Modified Davis classification
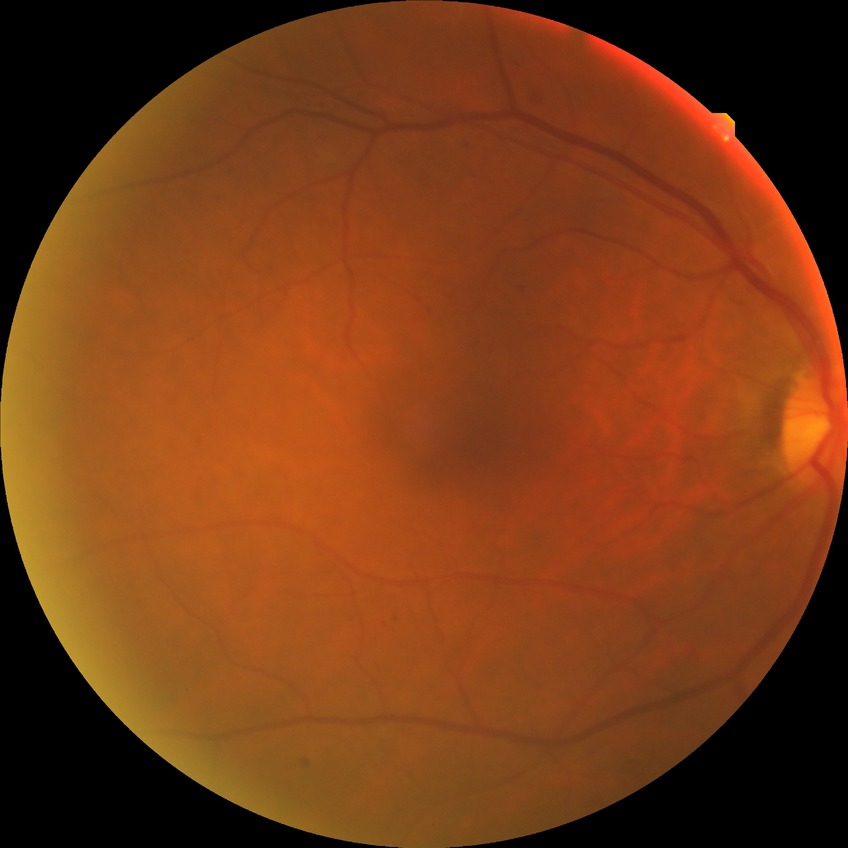

diabetic retinopathy (DR): simple diabetic retinopathy (SDR).